UWF retinal mosaic.
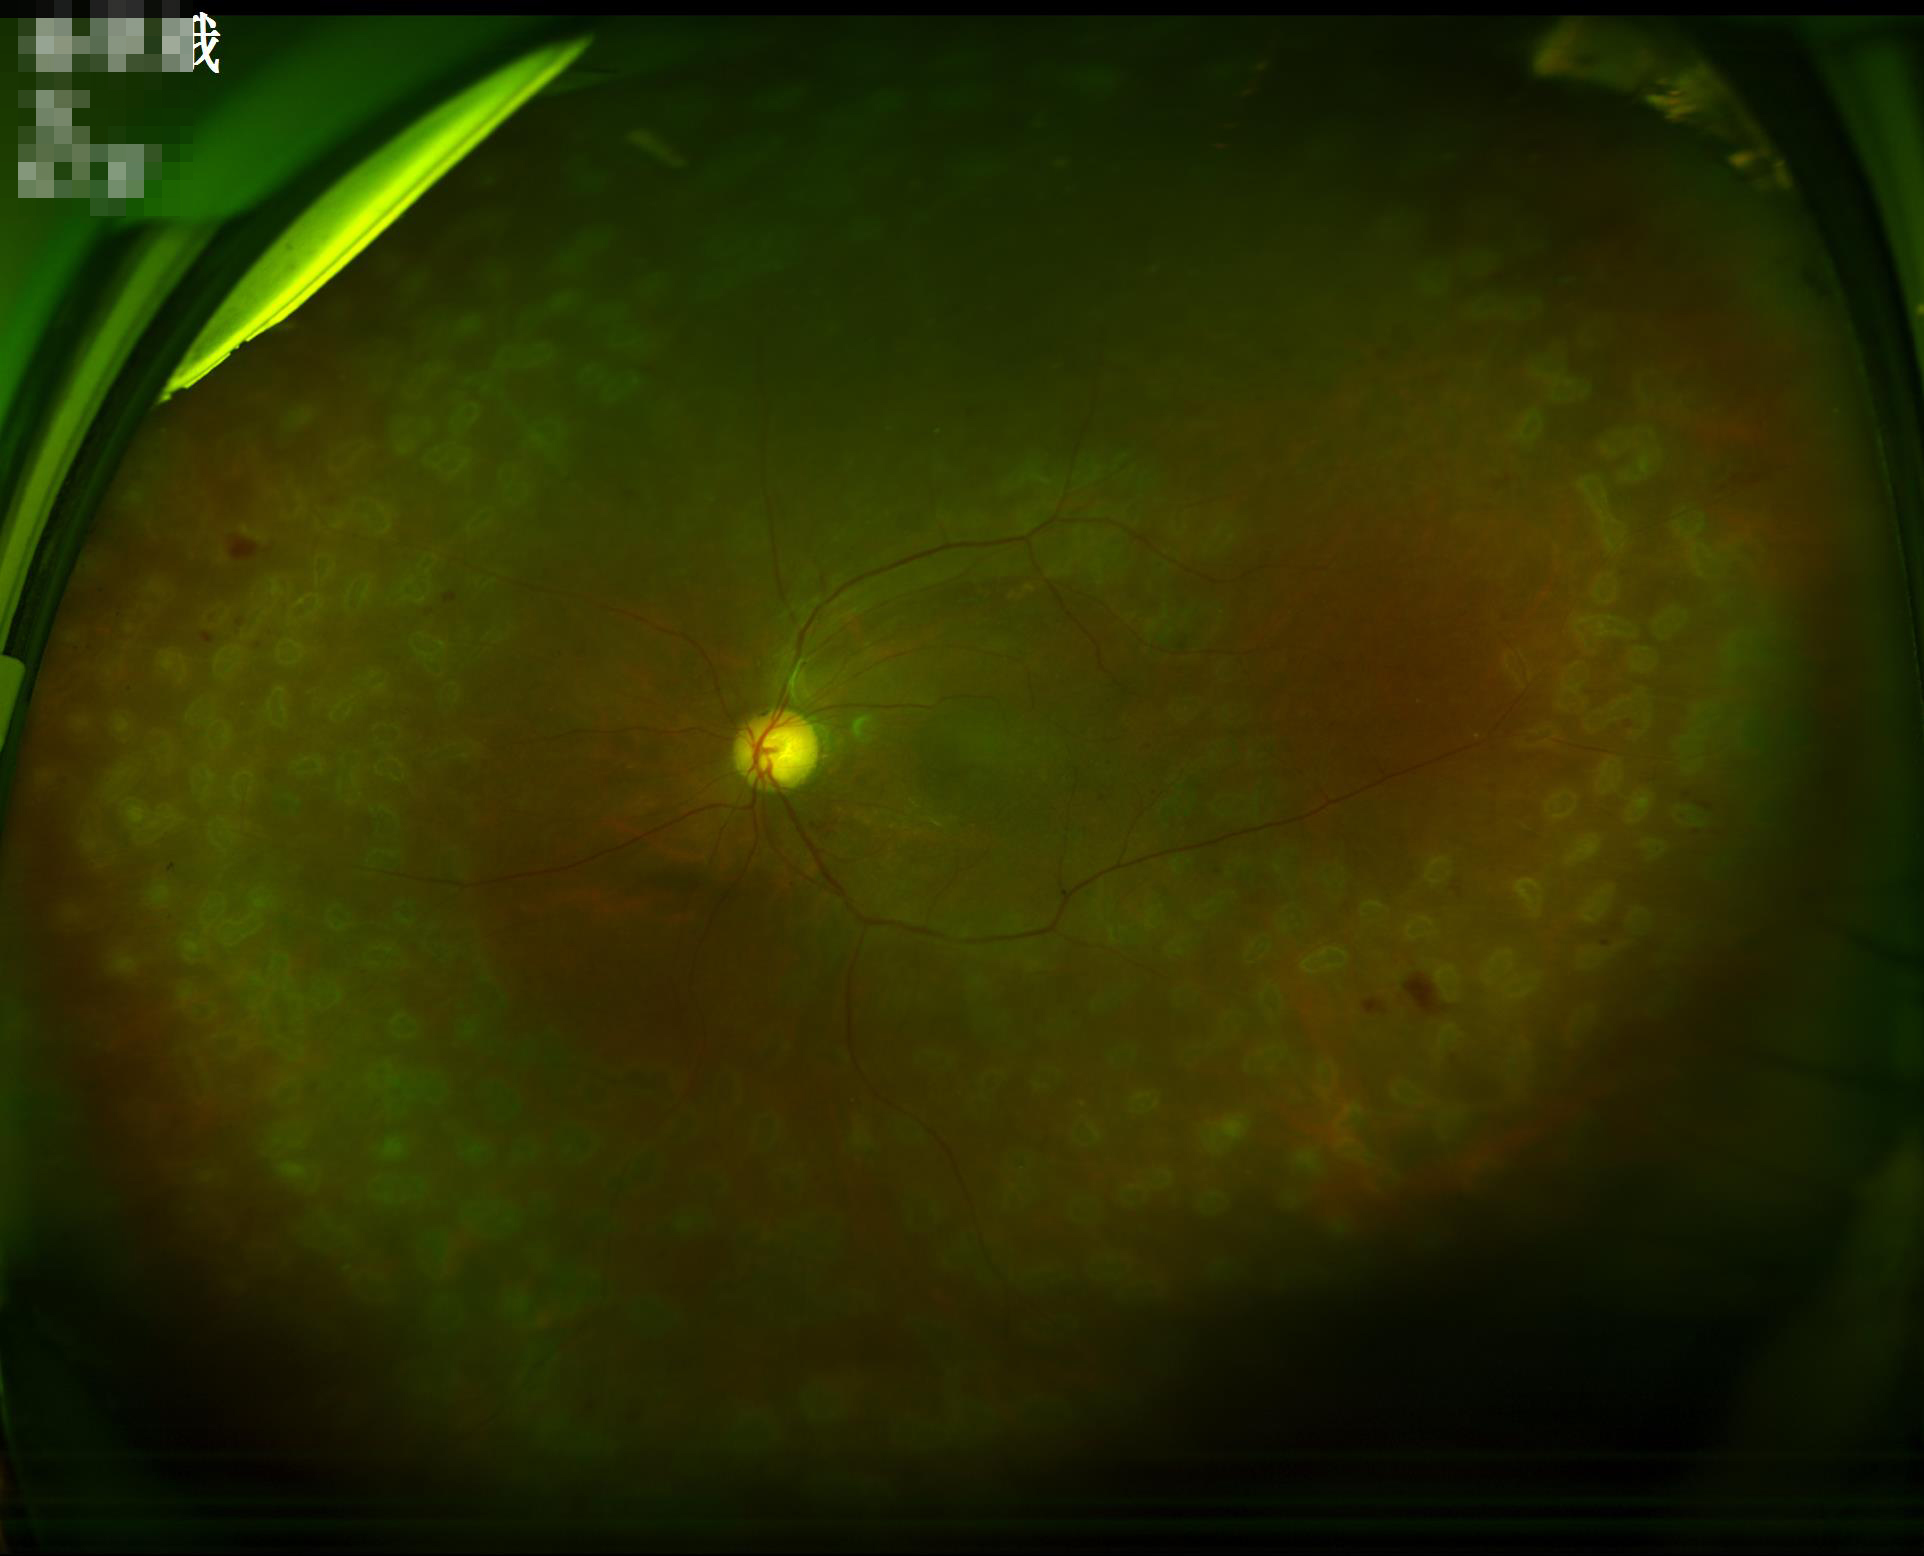
Adequate contrast for distinguishing structures. No over- or under-exposure. Optic disc, vessels, and background are in focus. Overall image quality is good.